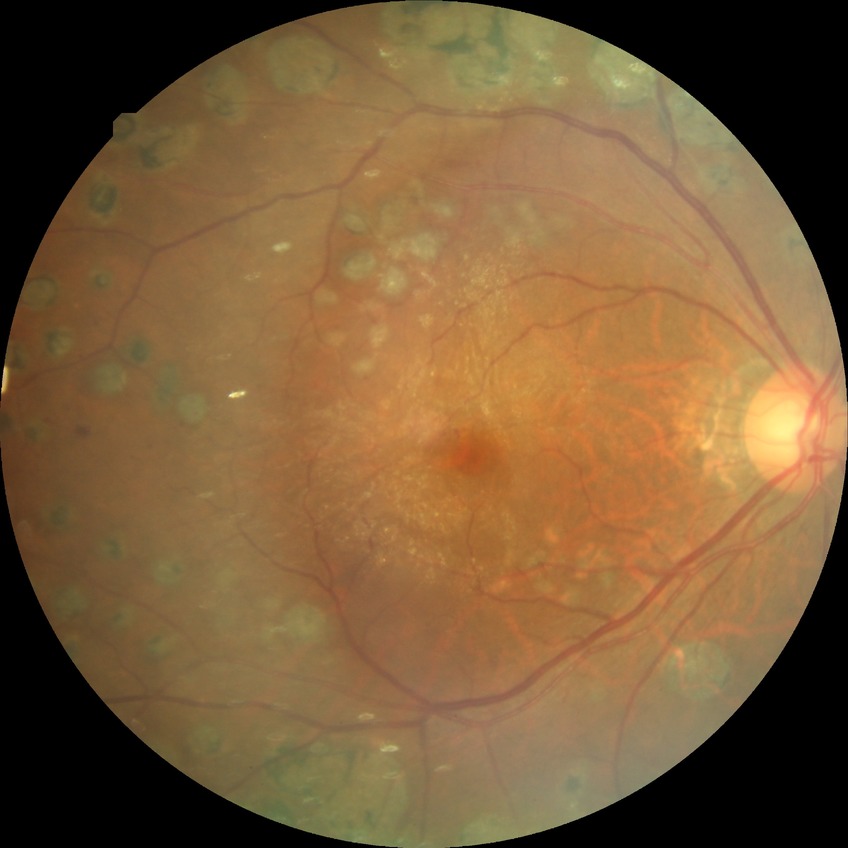 diabetic retinopathy (DR): proliferative diabetic retinopathy (PDR).